45-degree field of view
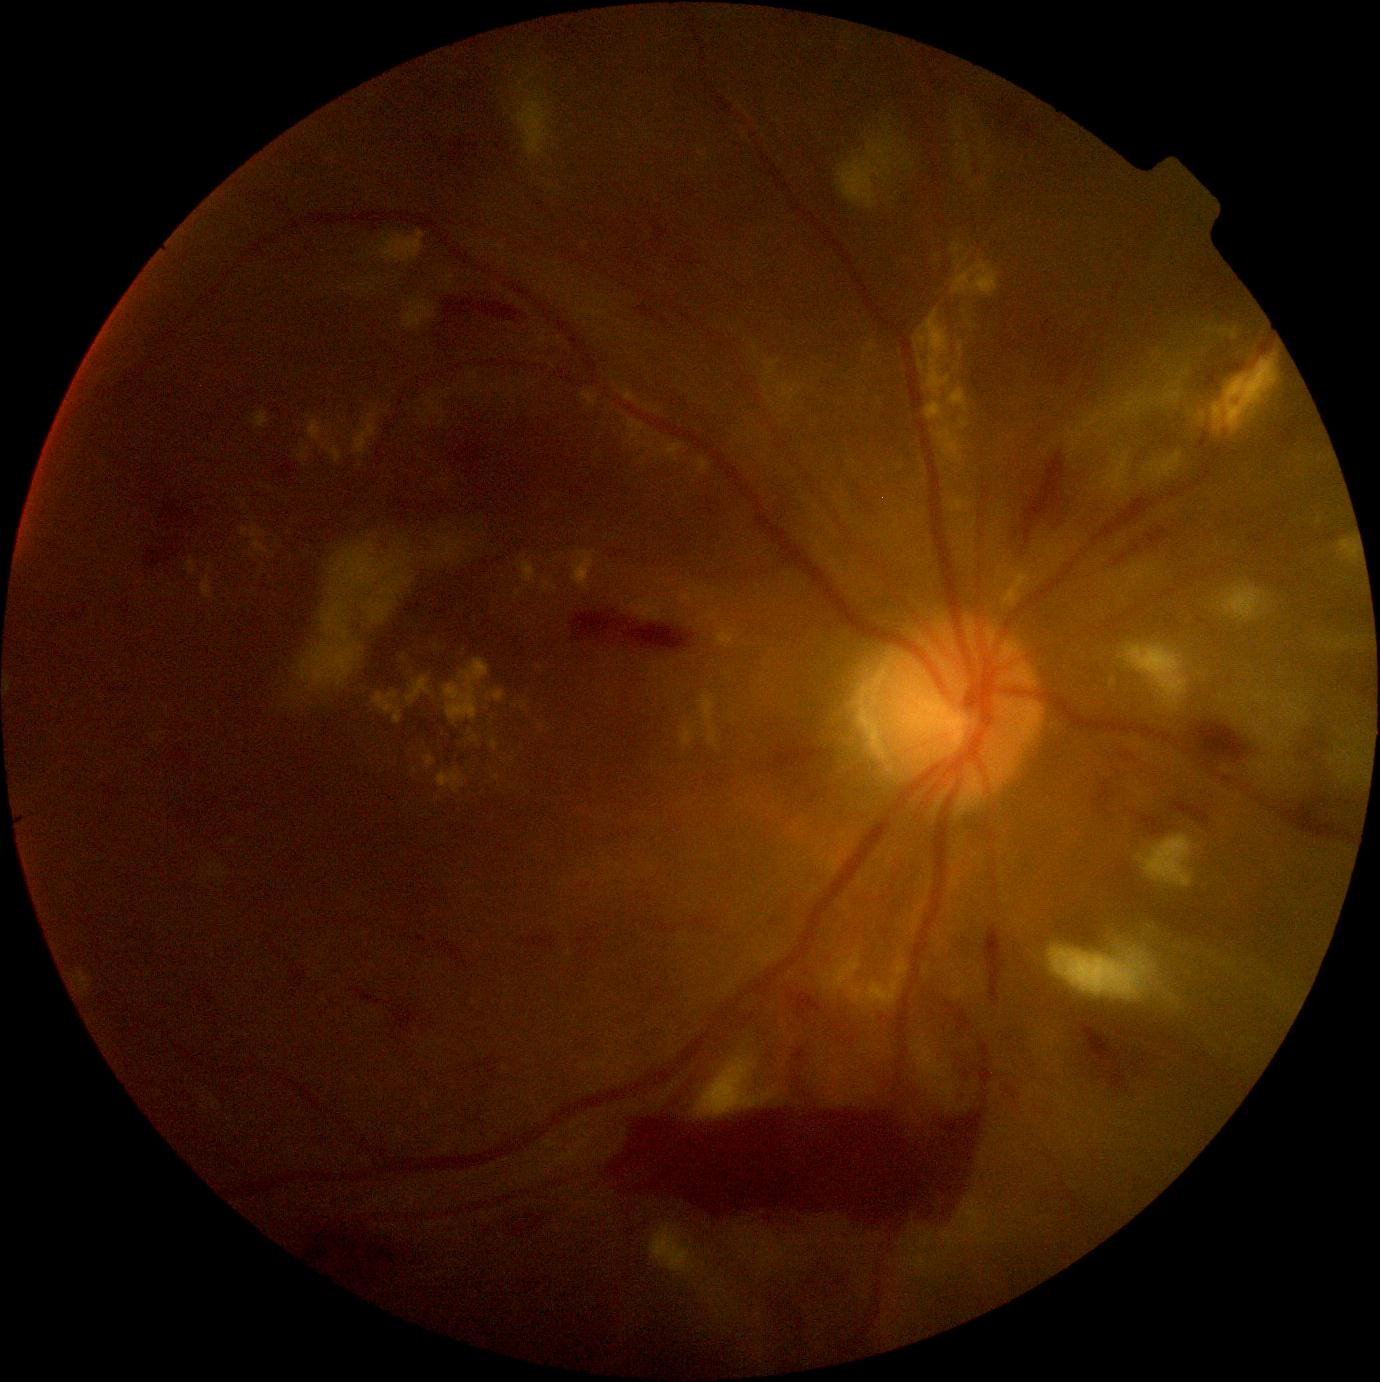

DR severity is 4.
SEs include 1281 765 1285 774 | 1252 692 1270 709 | 1122 391 1182 418 | 695 1059 773 1118 | 1049 918 1198 1011 | 1281 704 1287 714 | 513 94 552 158 | 1260 762 1274 780 | 1244 707 1251 719 | 1071 439 1080 452 | 1254 714 1276 737.
Additional small SEs near point(1166, 390) | point(1282, 742) | point(1333, 763) | point(1123, 495) | point(1271, 694) | point(1181, 384).
EXs include 696 458 711 474 | 624 389 636 402 | 241 525 275 557 | 308 420 327 441 | 581 391 598 408 | 520 701 528 711 | 1195 352 1284 440 | 424 755 436 770 | 436 769 466 794 | 404 301 435 331 | 494 774 500 782.
Additional small EXs near point(644, 460) | point(640, 444) | point(328, 434) | point(657, 462) | point(253, 556).